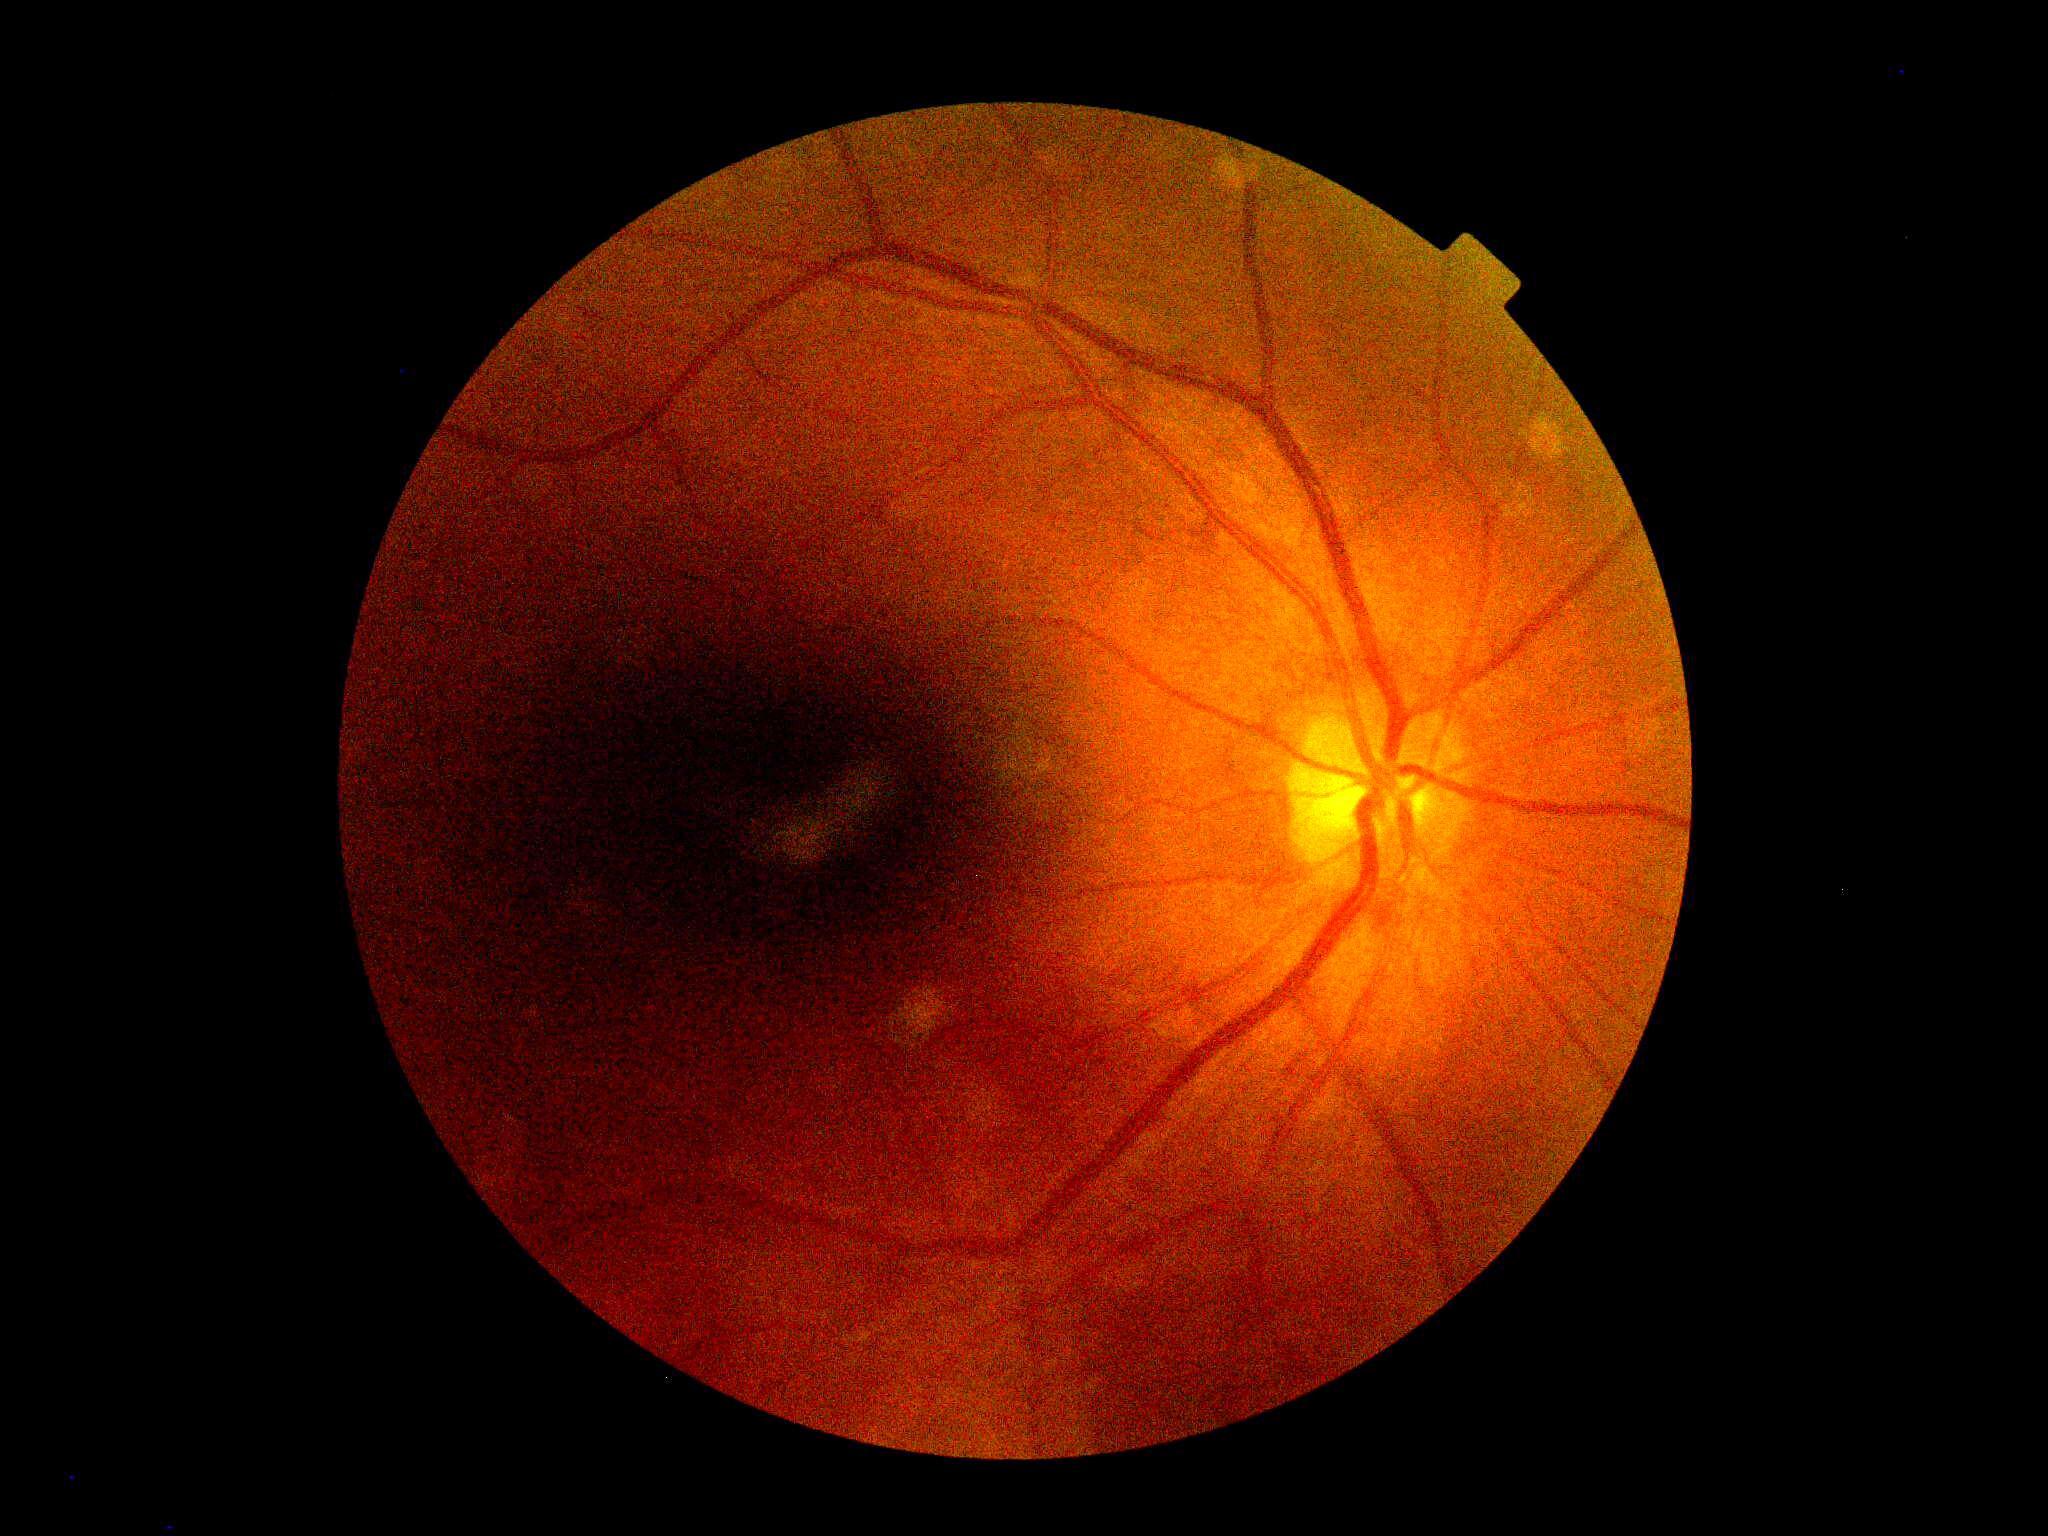 {
  "dr_grade": "no apparent retinopathy (grade 0)"
}